1240 by 1240 pixels · wide-field fundus photograph of an infant · captured with the Phoenix ICON (100° field of view):
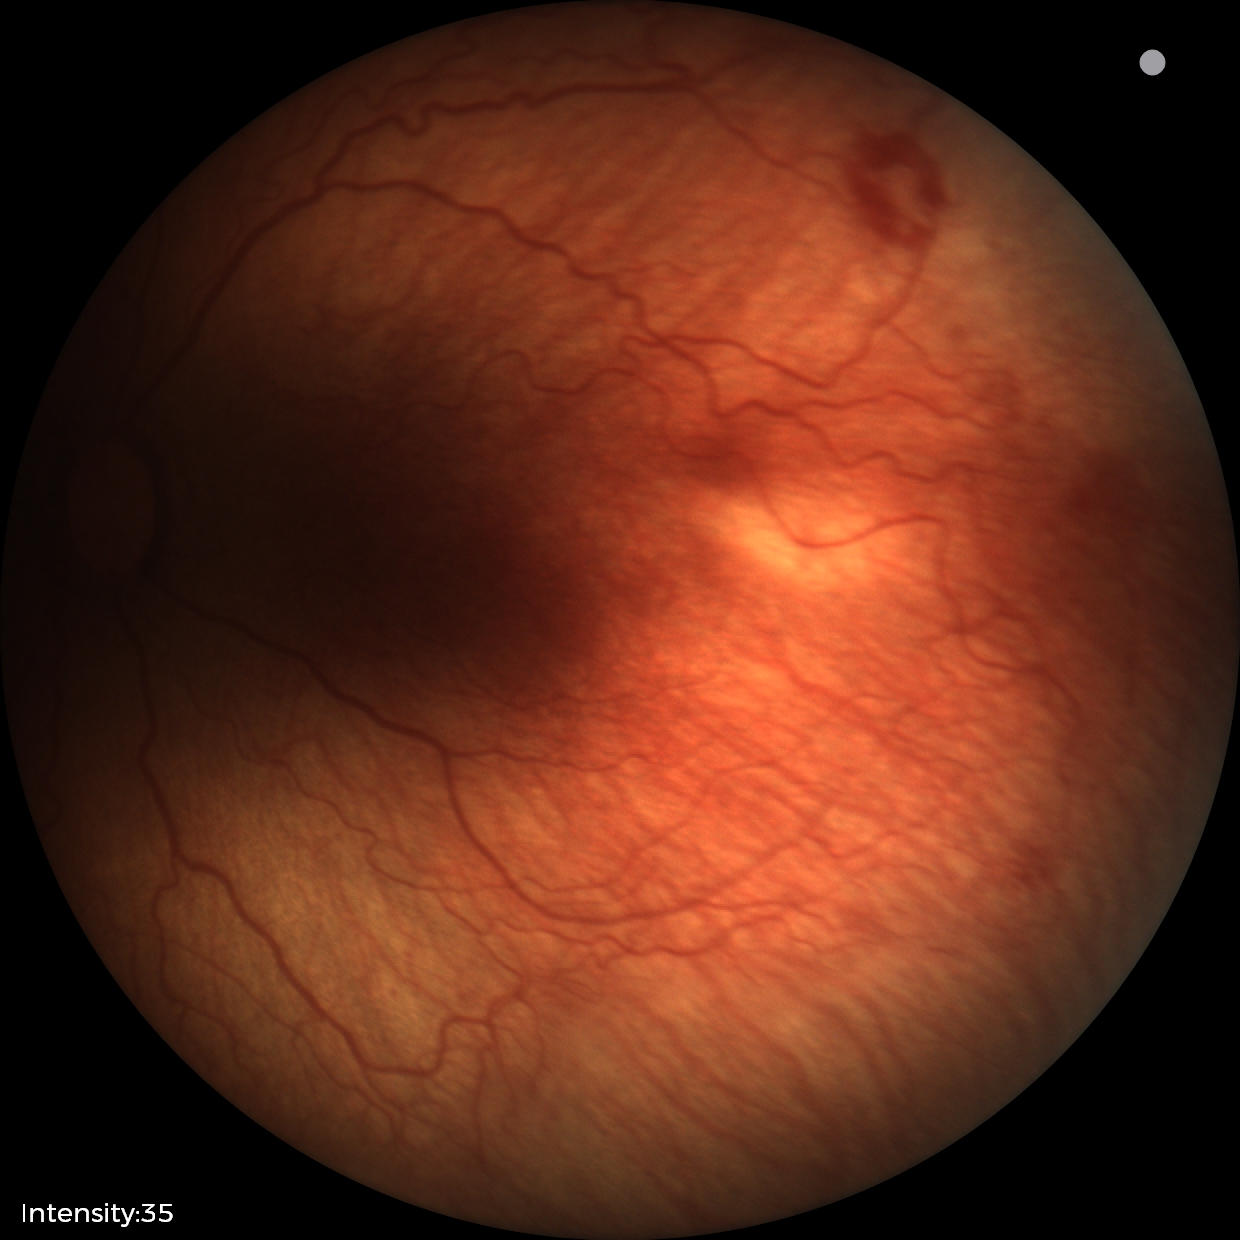

Assessment: ROP stage 2.